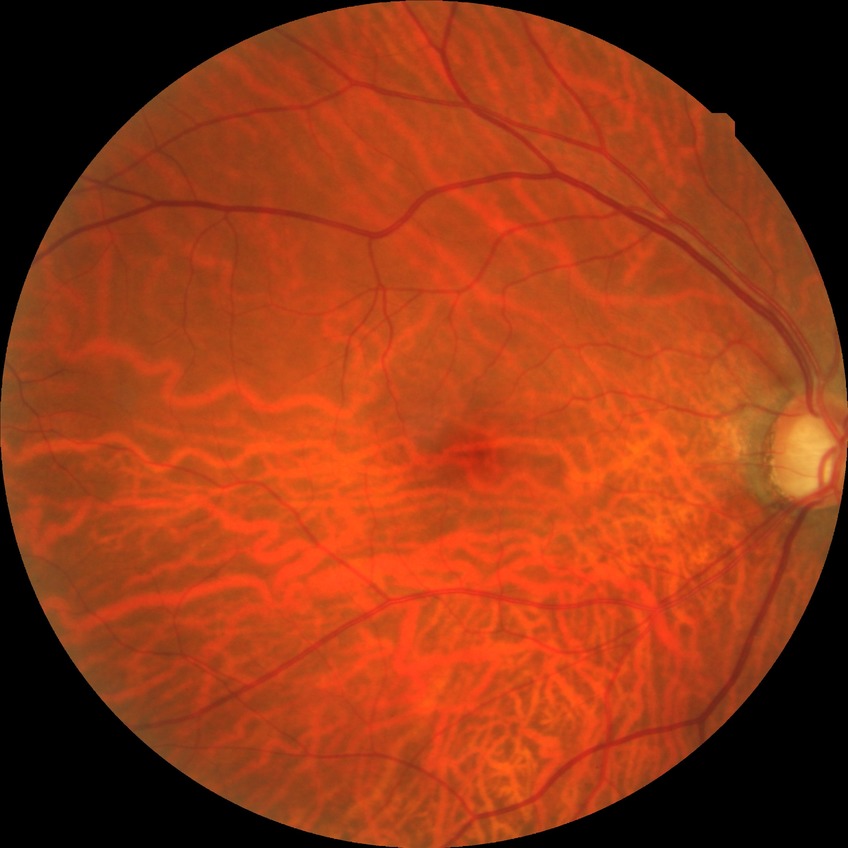

Diabetic retinopathy (DR) is no diabetic retinopathy (NDR).